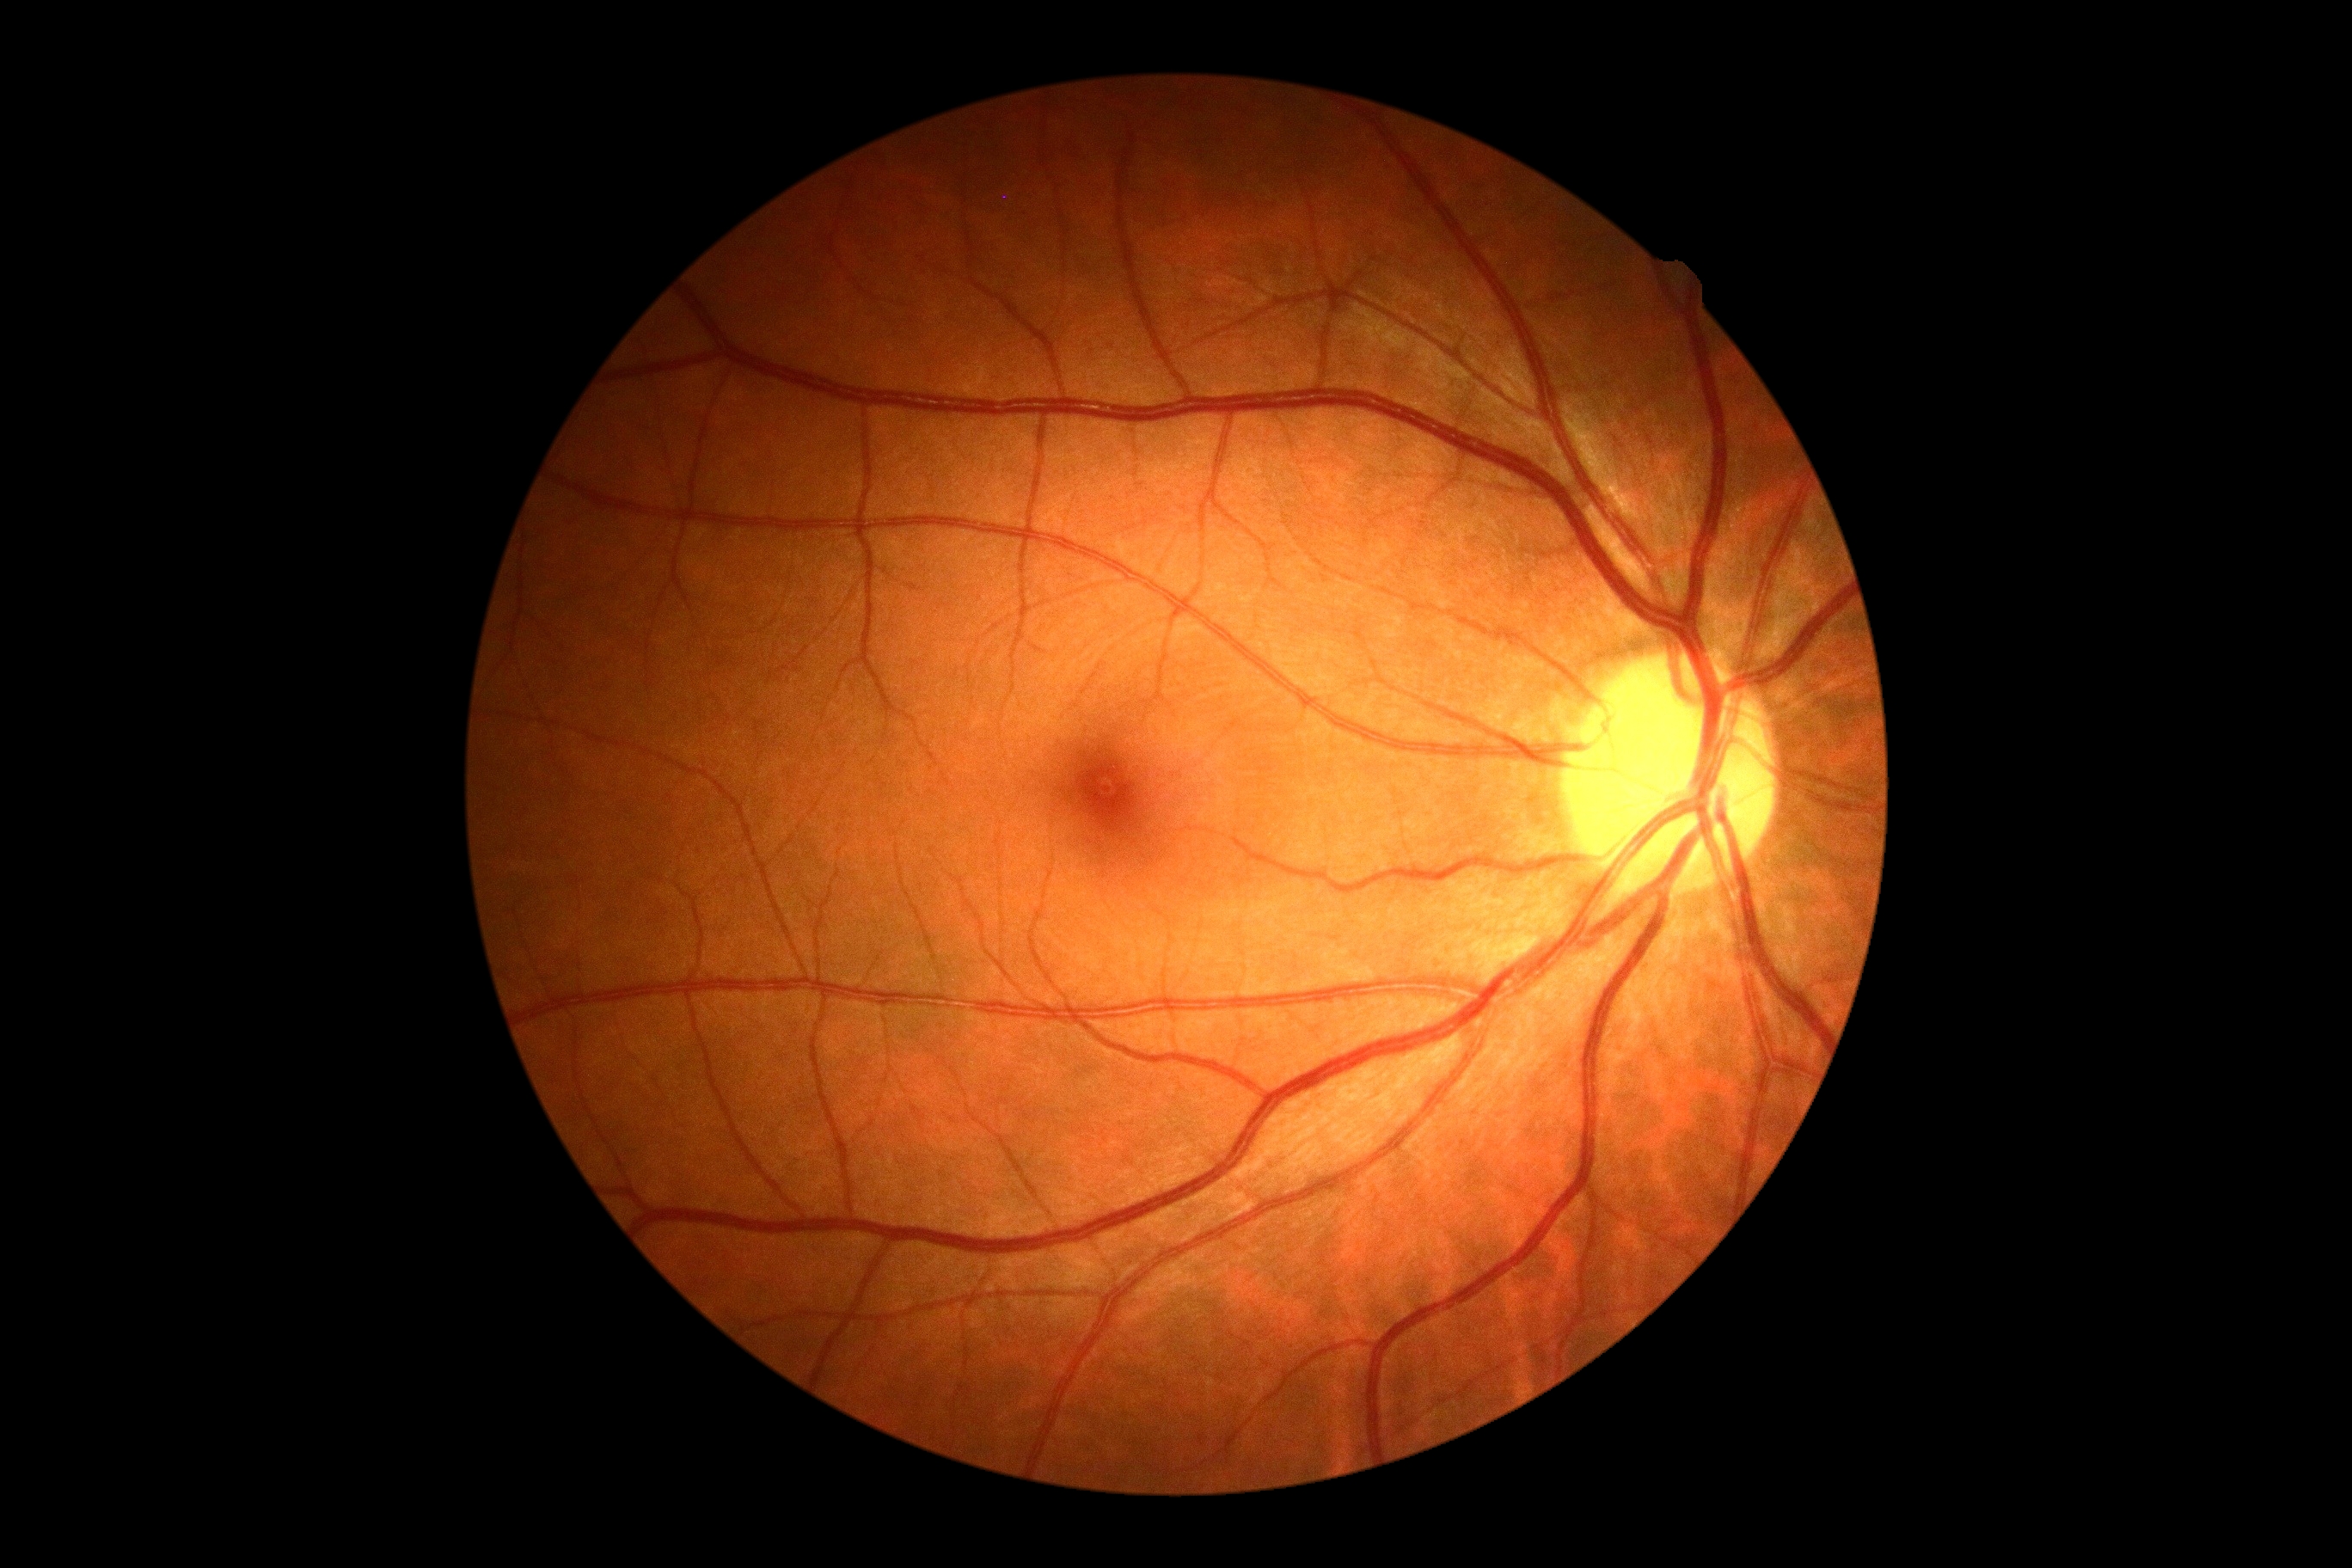
  dr_grade: no apparent diabetic retinopathy (grade 0)
  dr_impression: no DR findings